2352x1568 — 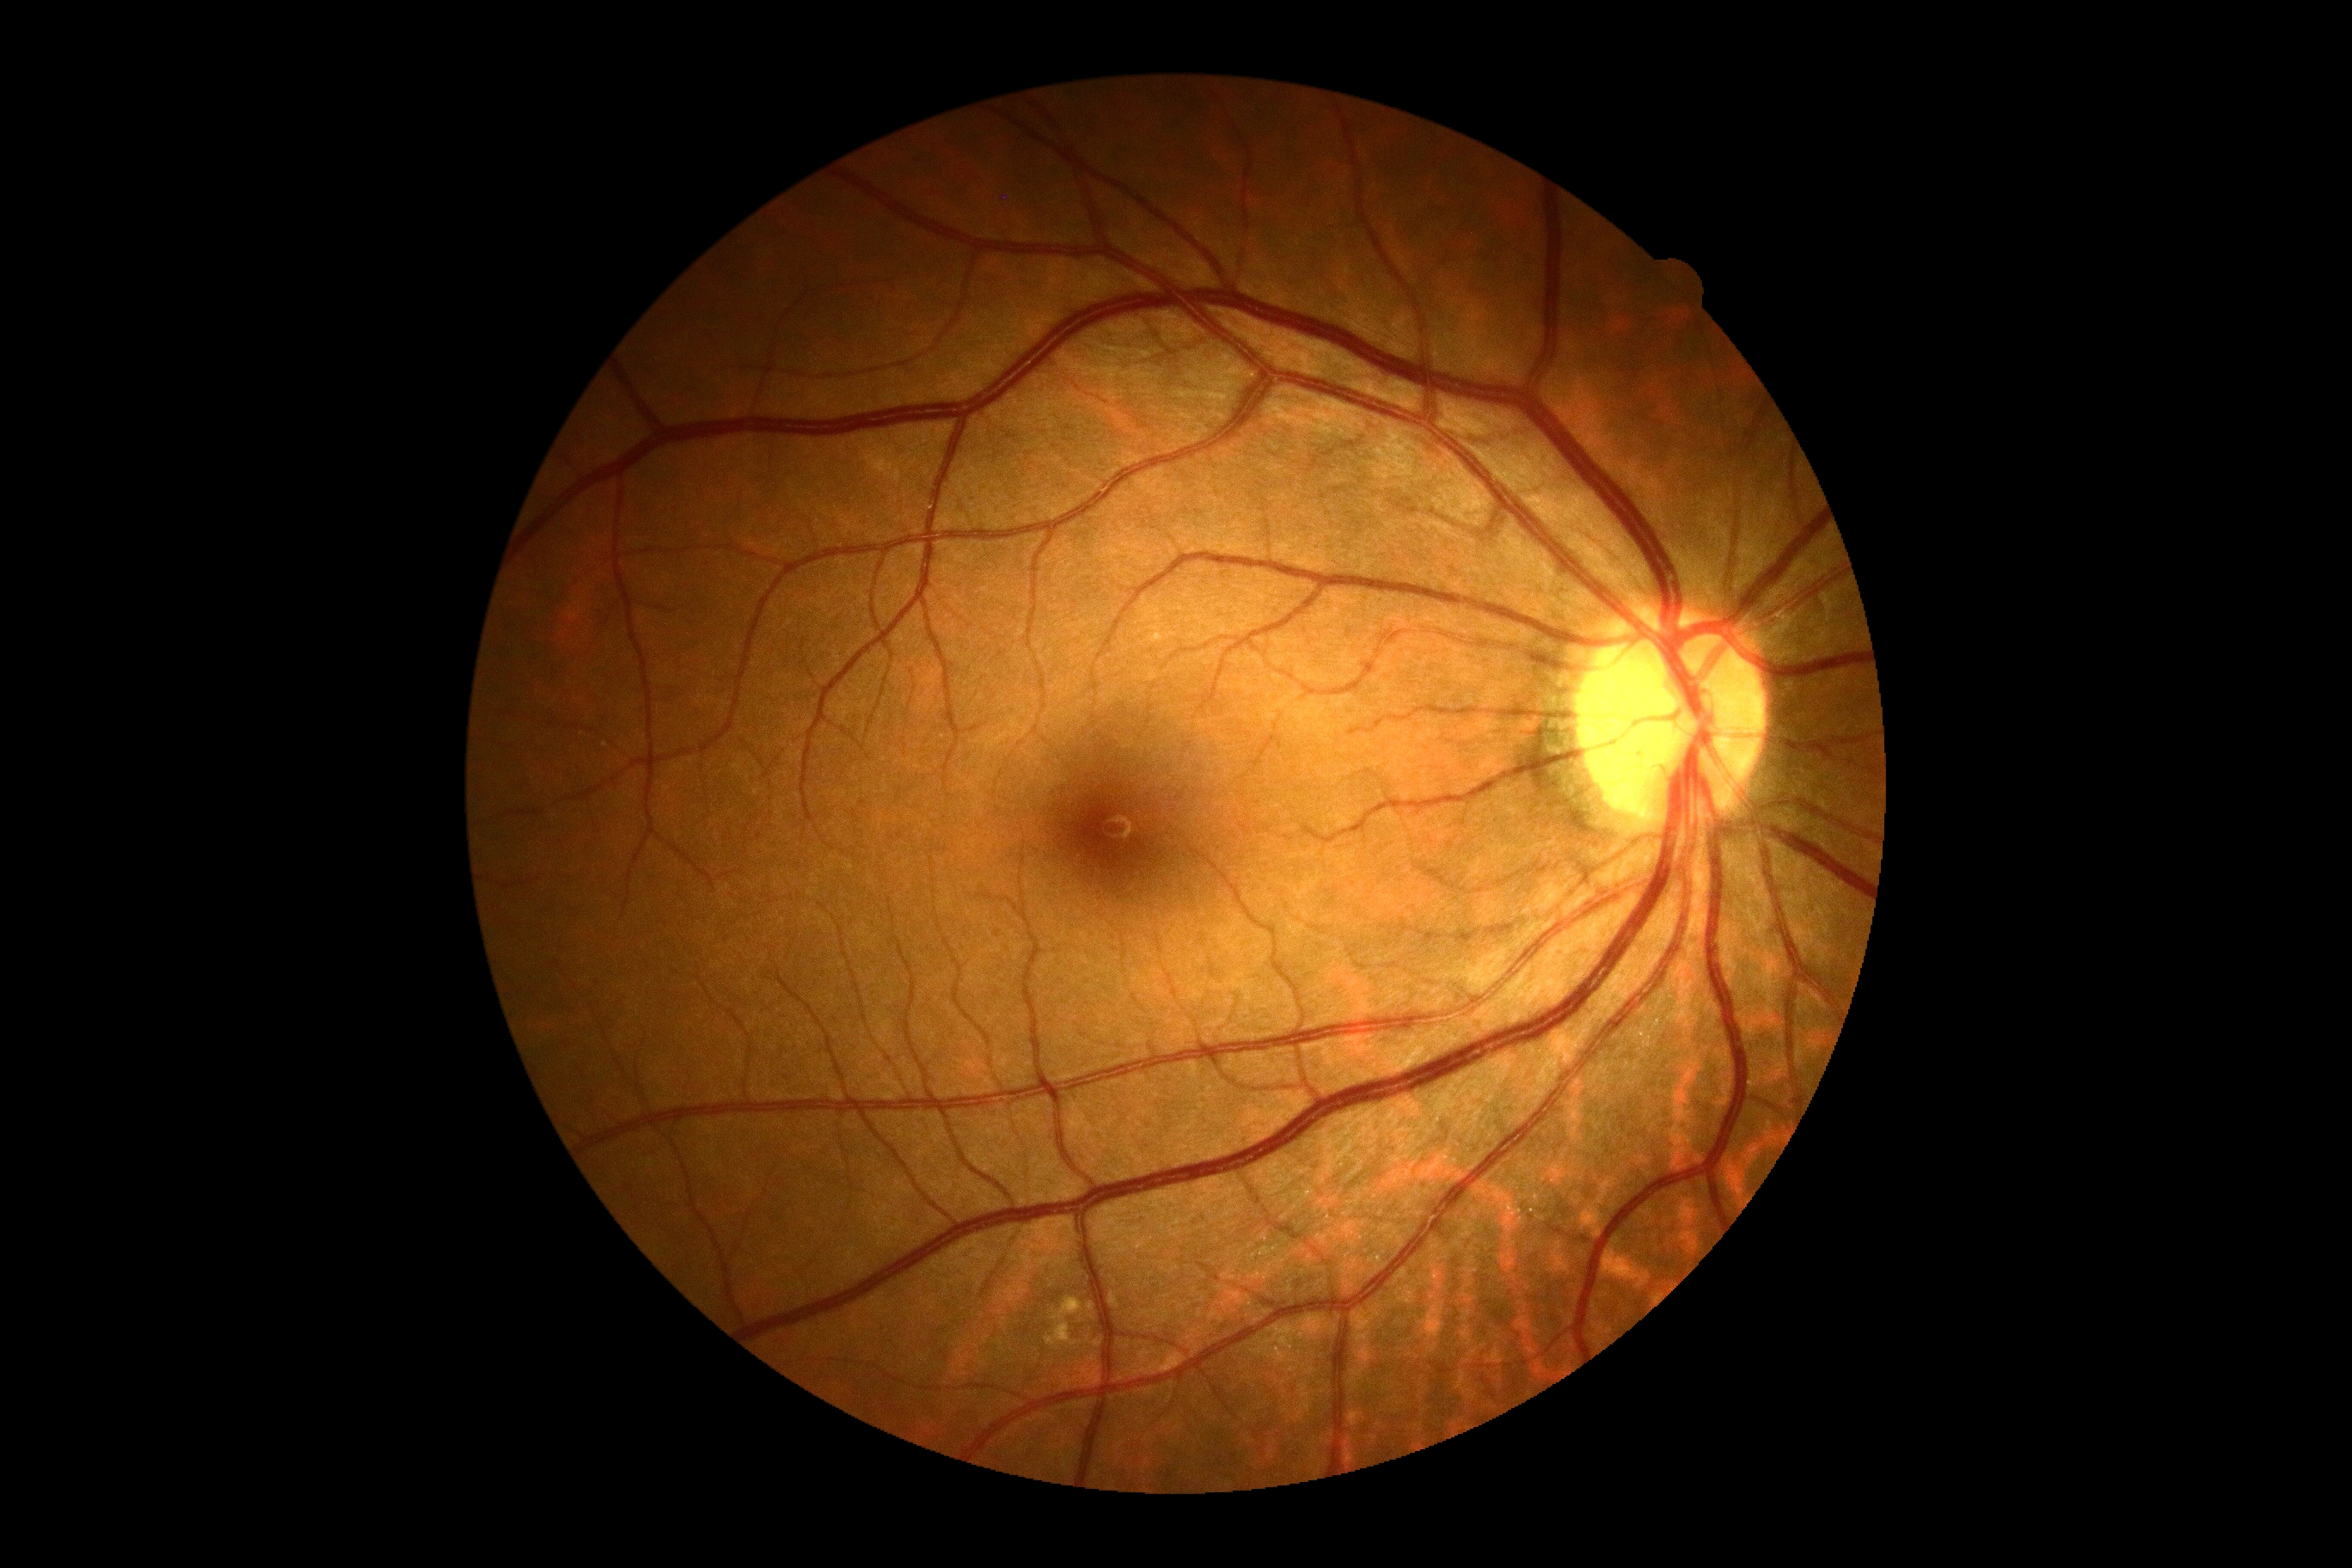
Diabetic retinopathy (DR) is grade 0 (no apparent retinopathy).
No signs of diabetic retinopathy.